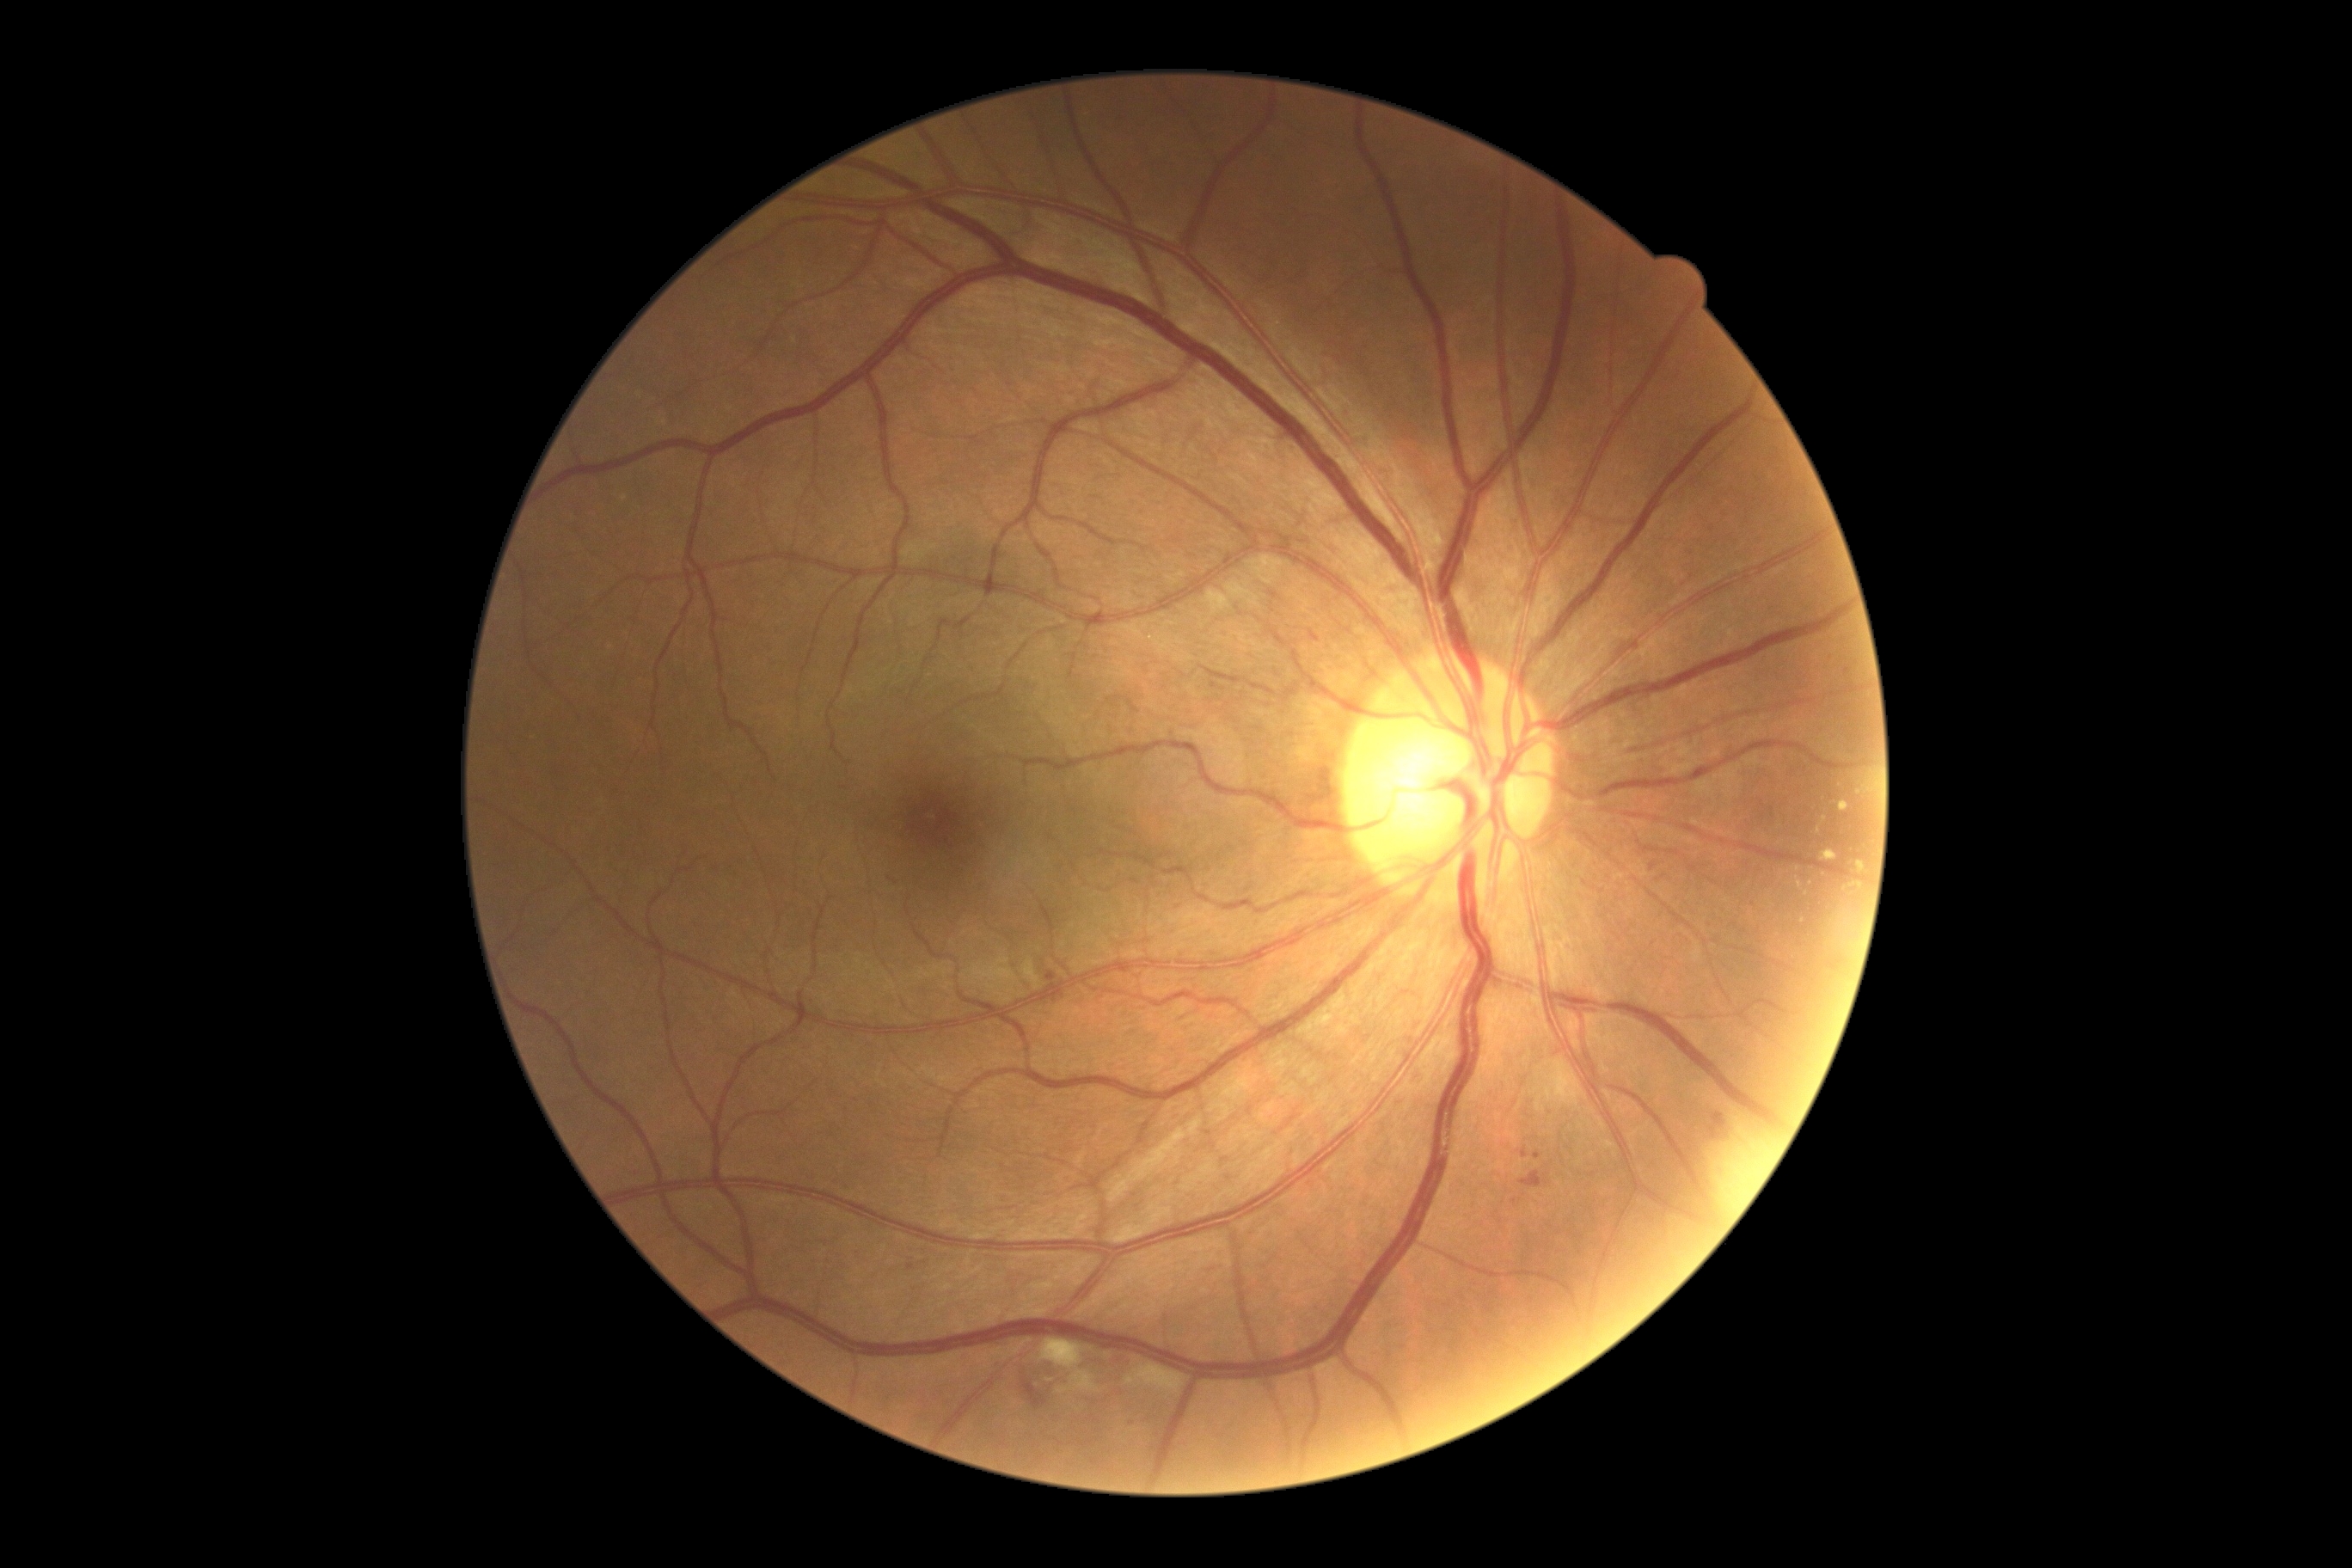
DR grade: 2 (moderate NPDR). EXs include those at 1822:850:1837:862; 1858:861:1866:874; 1839:800:1849:812; 1851:881:1865:890. Small EXs near x=1819 y=832; x=1803 y=922; x=1846 y=889; x=1800 y=885; x=1825 y=819; x=1049 y=1381. HEs identified at 1519:1170:1548:1189; 1708:1112:1725:1139; 1022:1378:1048:1411. MAs include those at 1311:630:1318:639; 1521:1148:1528:1158; 907:1265:916:1271; 1046:972:1058:983; 1533:1153:1541:1161; 1651:862:1658:873. Small MAs near x=843 y=788; x=1135 y=1426. SEs identified at 1125:1364:1185:1397; 1039:1340:1101:1395.